Fundus photo — 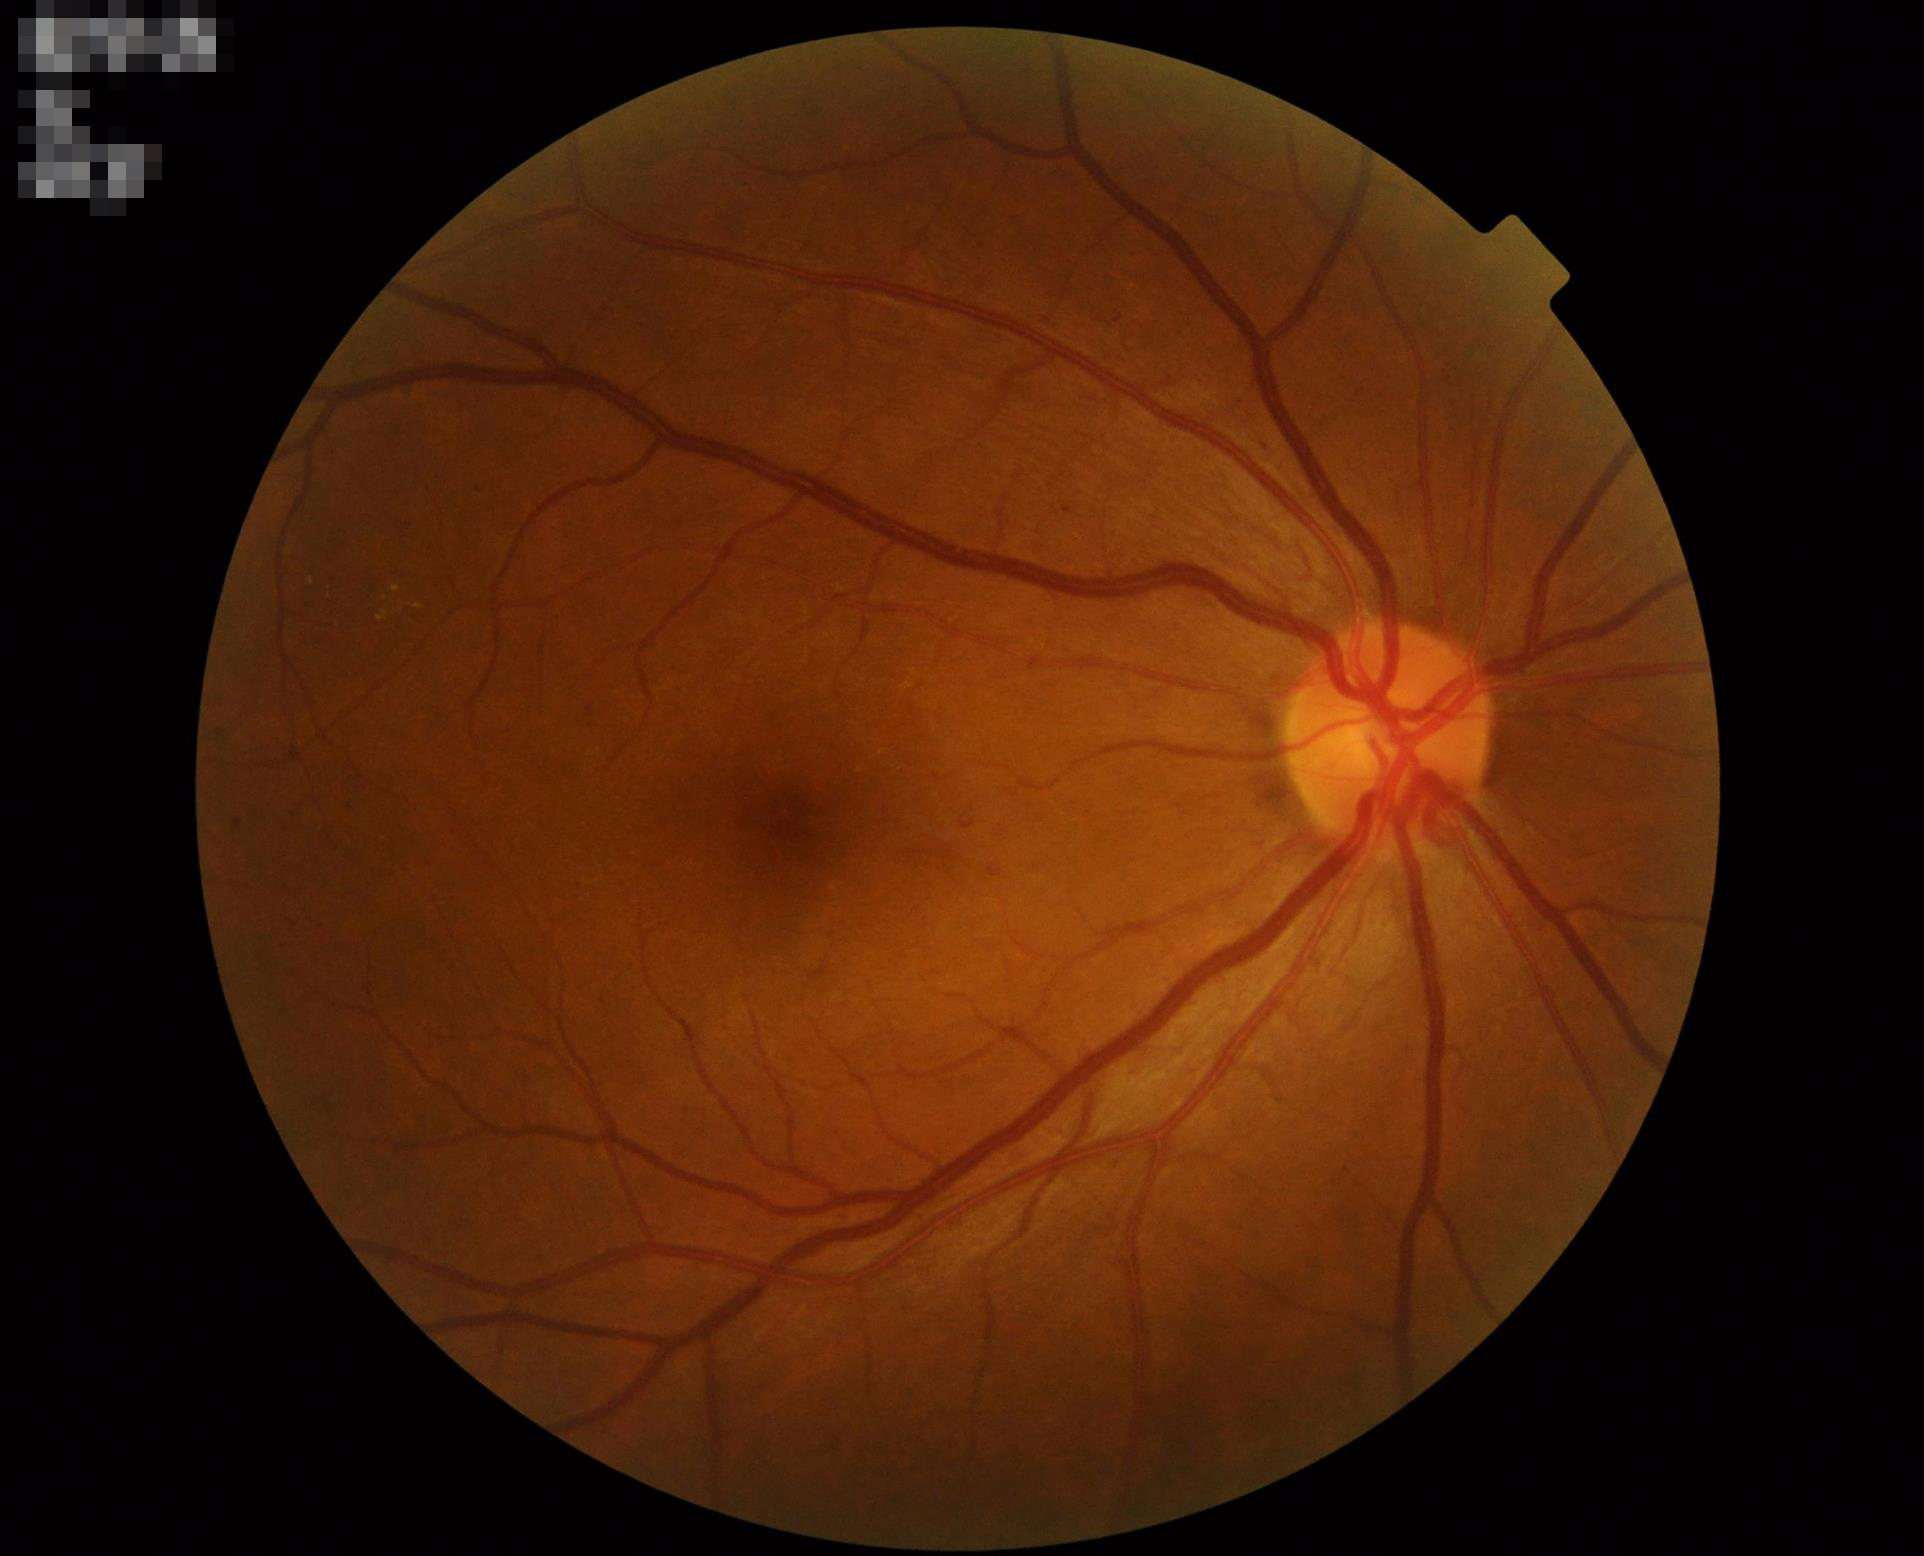 Illumination and color balance are good. Good dynamic range. No noticeable blur. Overall image quality is good.